NIDEK AFC-230 · 848 by 848 pixels · posterior pole color fundus photograph · 45° FOV.
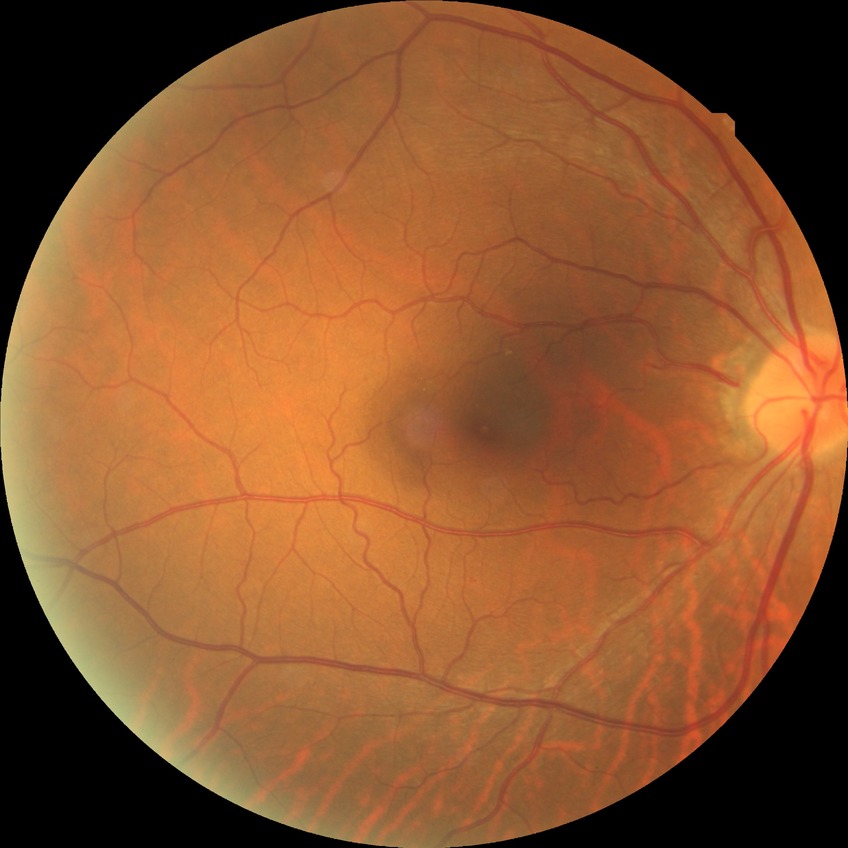 Annotations:
* diabetic retinopathy (DR): NDR (no diabetic retinopathy)